45° FOV, color fundus photograph, 2048x1536px:
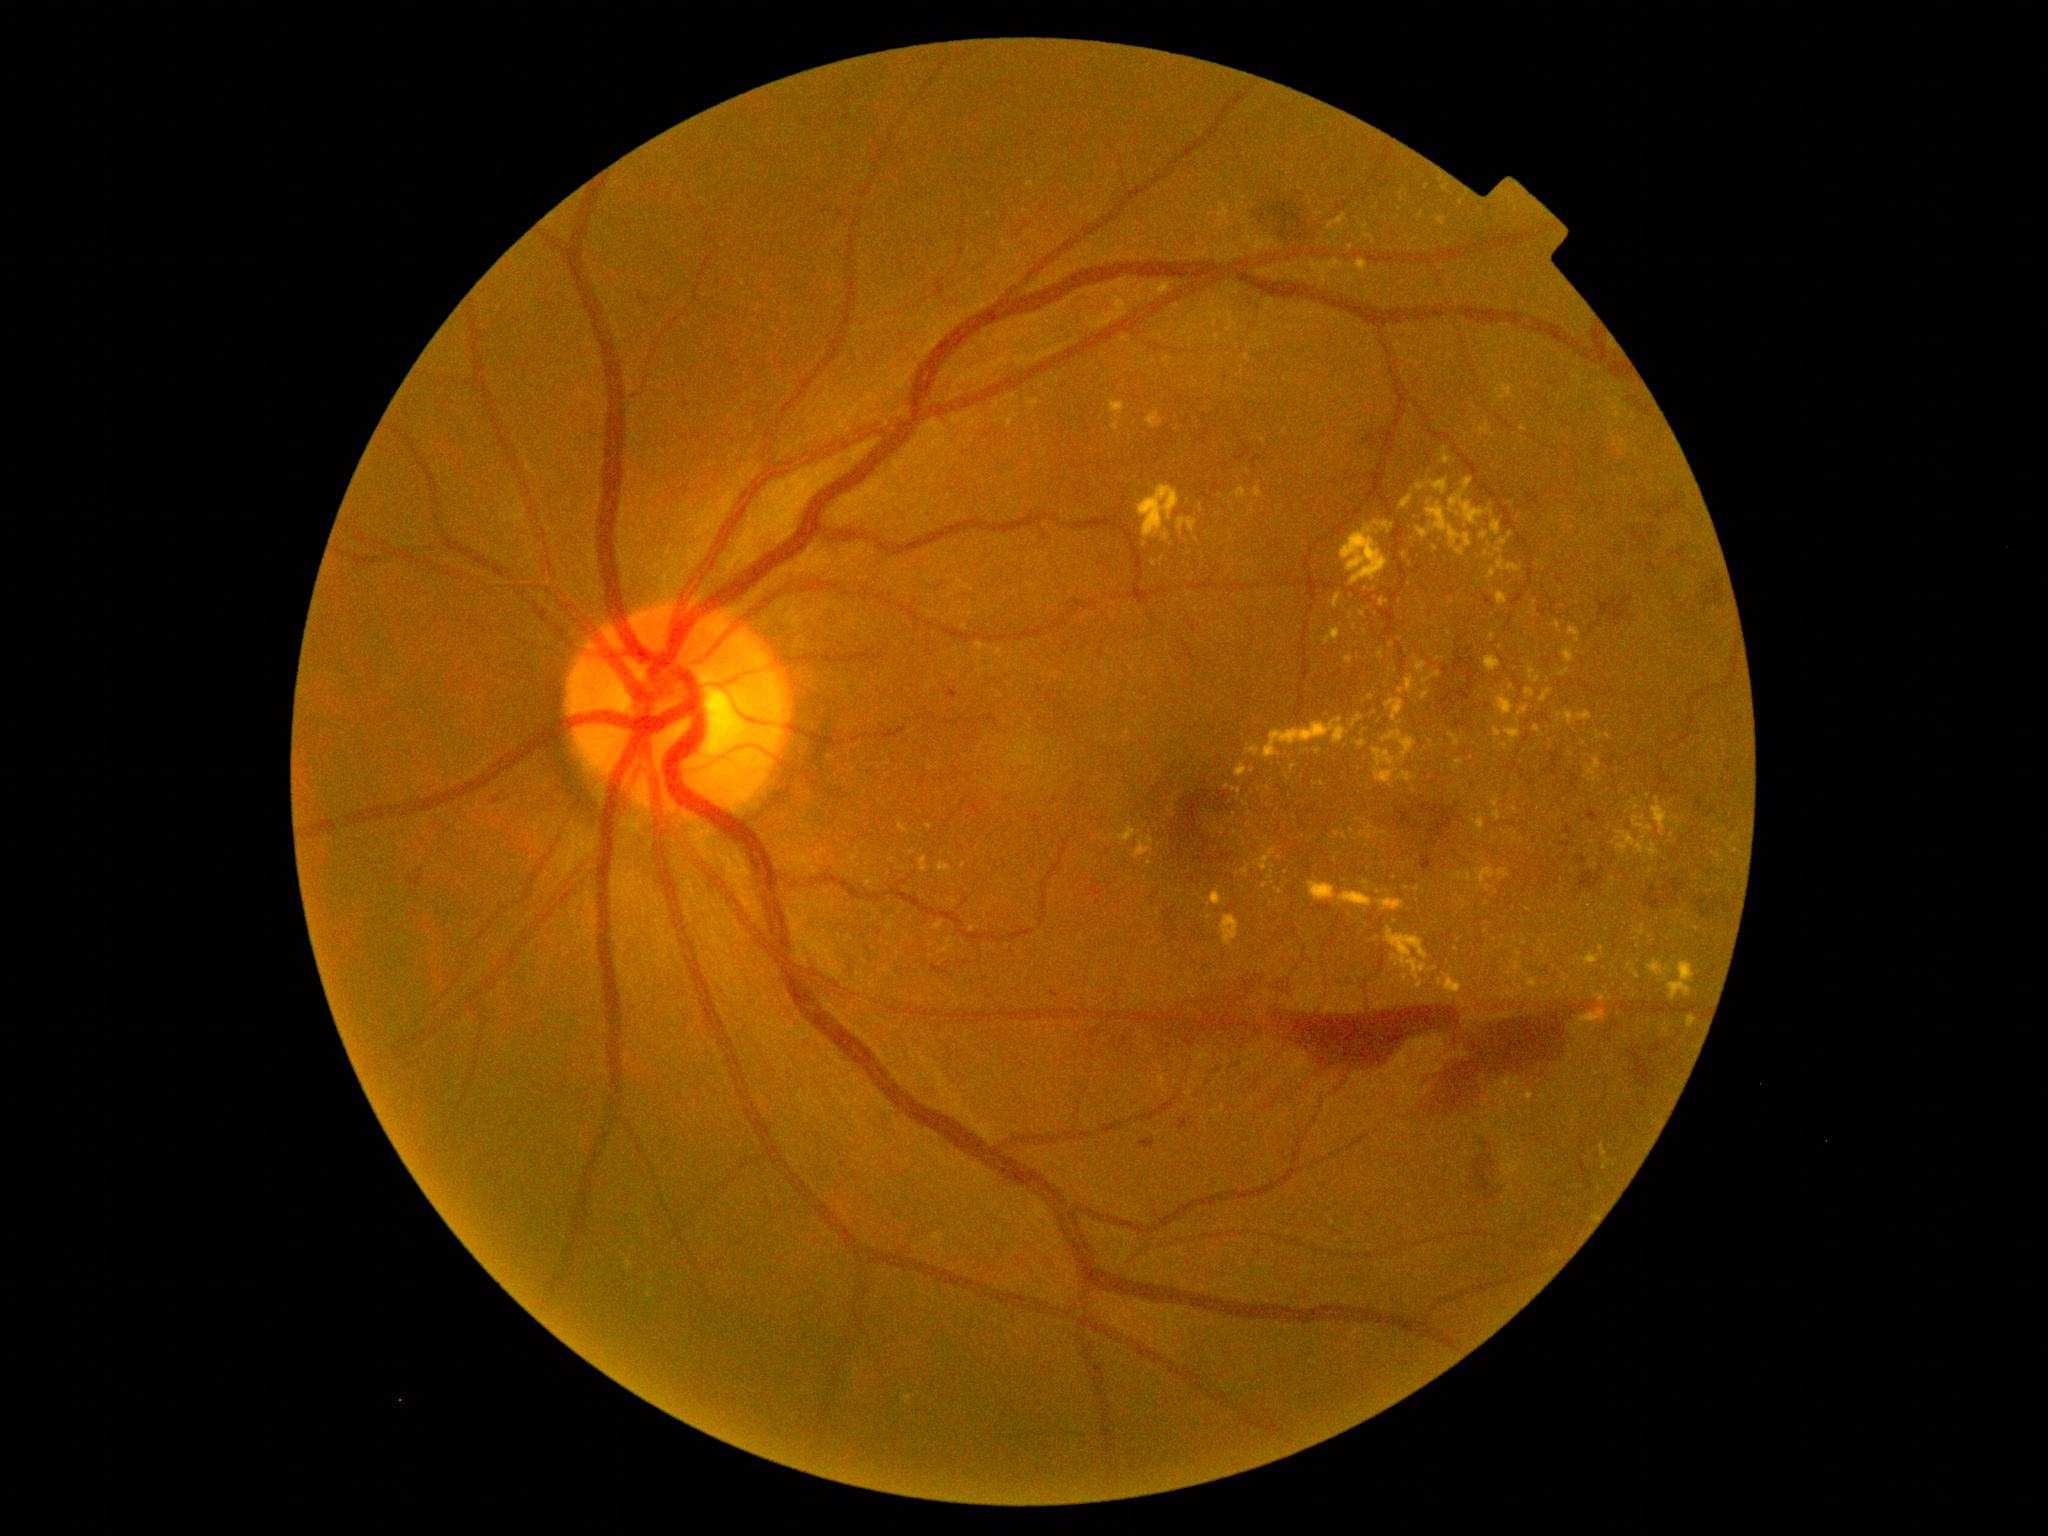
DR grade is 4/4
Representative lesions:
MAs: (x1=1562, y1=825, x2=1573, y2=836) | (x1=493, y1=798, x2=501, y2=807) | (x1=1705, y1=806, x2=1716, y2=819) | (x1=944, y1=689, x2=959, y2=702) | (x1=1178, y1=1117, x2=1194, y2=1131) | (x1=1695, y1=799, x2=1704, y2=813) | (x1=1139, y1=1137, x2=1156, y2=1150) | (x1=1050, y1=991, x2=1059, y2=998) | (x1=1483, y1=594, x2=1496, y2=609) | (x1=931, y1=965, x2=949, y2=975) | (x1=1586, y1=810, x2=1603, y2=823)
SEs: none detected
EXs (partial): (x1=1341, y1=521, x2=1394, y2=587) | (x1=1579, y1=712, x2=1592, y2=722) | (x1=1497, y1=560, x2=1504, y2=571) | (x1=1380, y1=899, x2=1404, y2=912) | (x1=1310, y1=882, x2=1337, y2=901) | (x1=1486, y1=657, x2=1501, y2=672) | (x1=1334, y1=594, x2=1341, y2=608) | (x1=1242, y1=869, x2=1249, y2=878) | (x1=1247, y1=746, x2=1261, y2=757)
Additional small EXs near point(630, 1265) | point(1525, 710) | point(1446, 449) | point(1197, 541) | point(1369, 237) | point(1528, 910) | point(1537, 729) | point(1523, 429) | point(1630, 966) | point(1293, 768)
HEs (partial): (x1=1694, y1=580, x2=1716, y2=607) | (x1=1545, y1=752, x2=1565, y2=776) | (x1=1473, y1=1150, x2=1500, y2=1213) | (x1=1423, y1=1010, x2=1576, y2=1116) | (x1=1696, y1=899, x2=1731, y2=918) | (x1=1473, y1=1140, x2=1484, y2=1151) | (x1=1570, y1=772, x2=1580, y2=790) | (x1=1661, y1=500, x2=1686, y2=517) | (x1=1257, y1=197, x2=1322, y2=249) | (x1=1610, y1=540, x2=1626, y2=557) | (x1=1598, y1=593, x2=1633, y2=628) | (x1=1098, y1=1031, x2=1126, y2=1045) | (x1=1272, y1=984, x2=1285, y2=995) | (x1=1165, y1=977, x2=1259, y2=1043) | (x1=1651, y1=567, x2=1659, y2=576)
Additional small HEs near point(1605, 851)